DR severity per modified Davis staging, 45° FOV
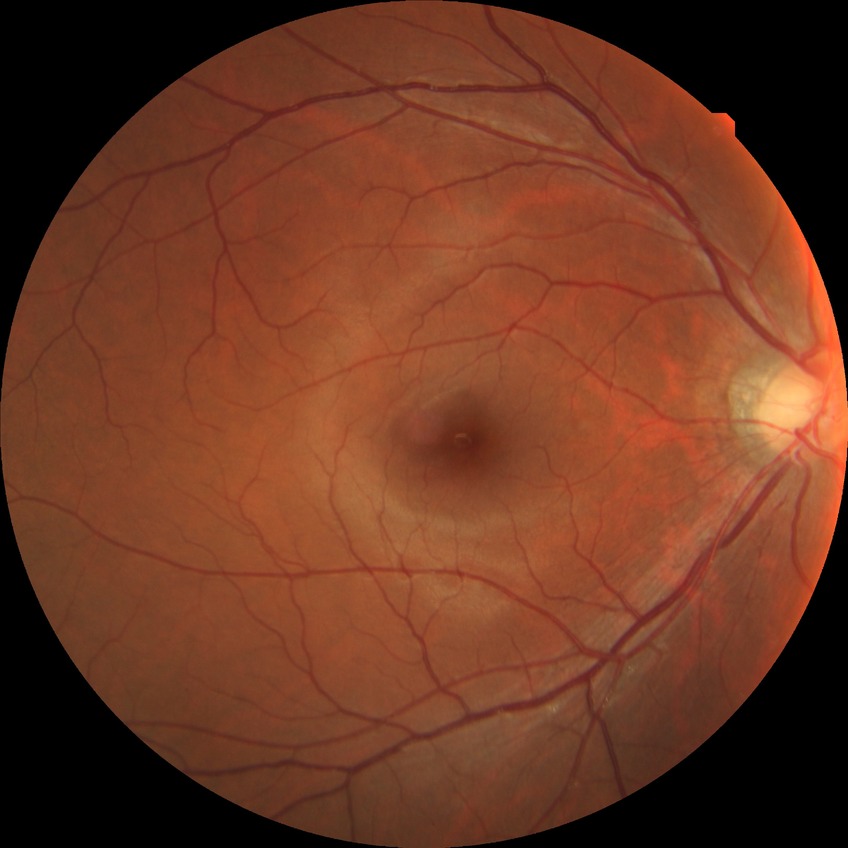 Diabetic retinopathy severity: no diabetic retinopathy.